Fundus photo:
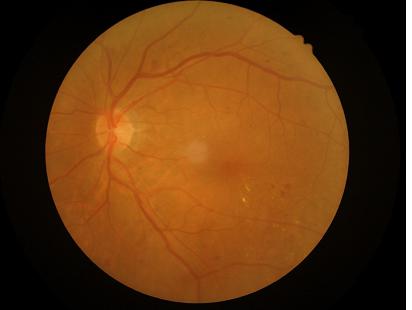

Optic disc, vessels, and background are in focus.
Even illumination with no color cast.
Image quality is adequate for diagnostic use.